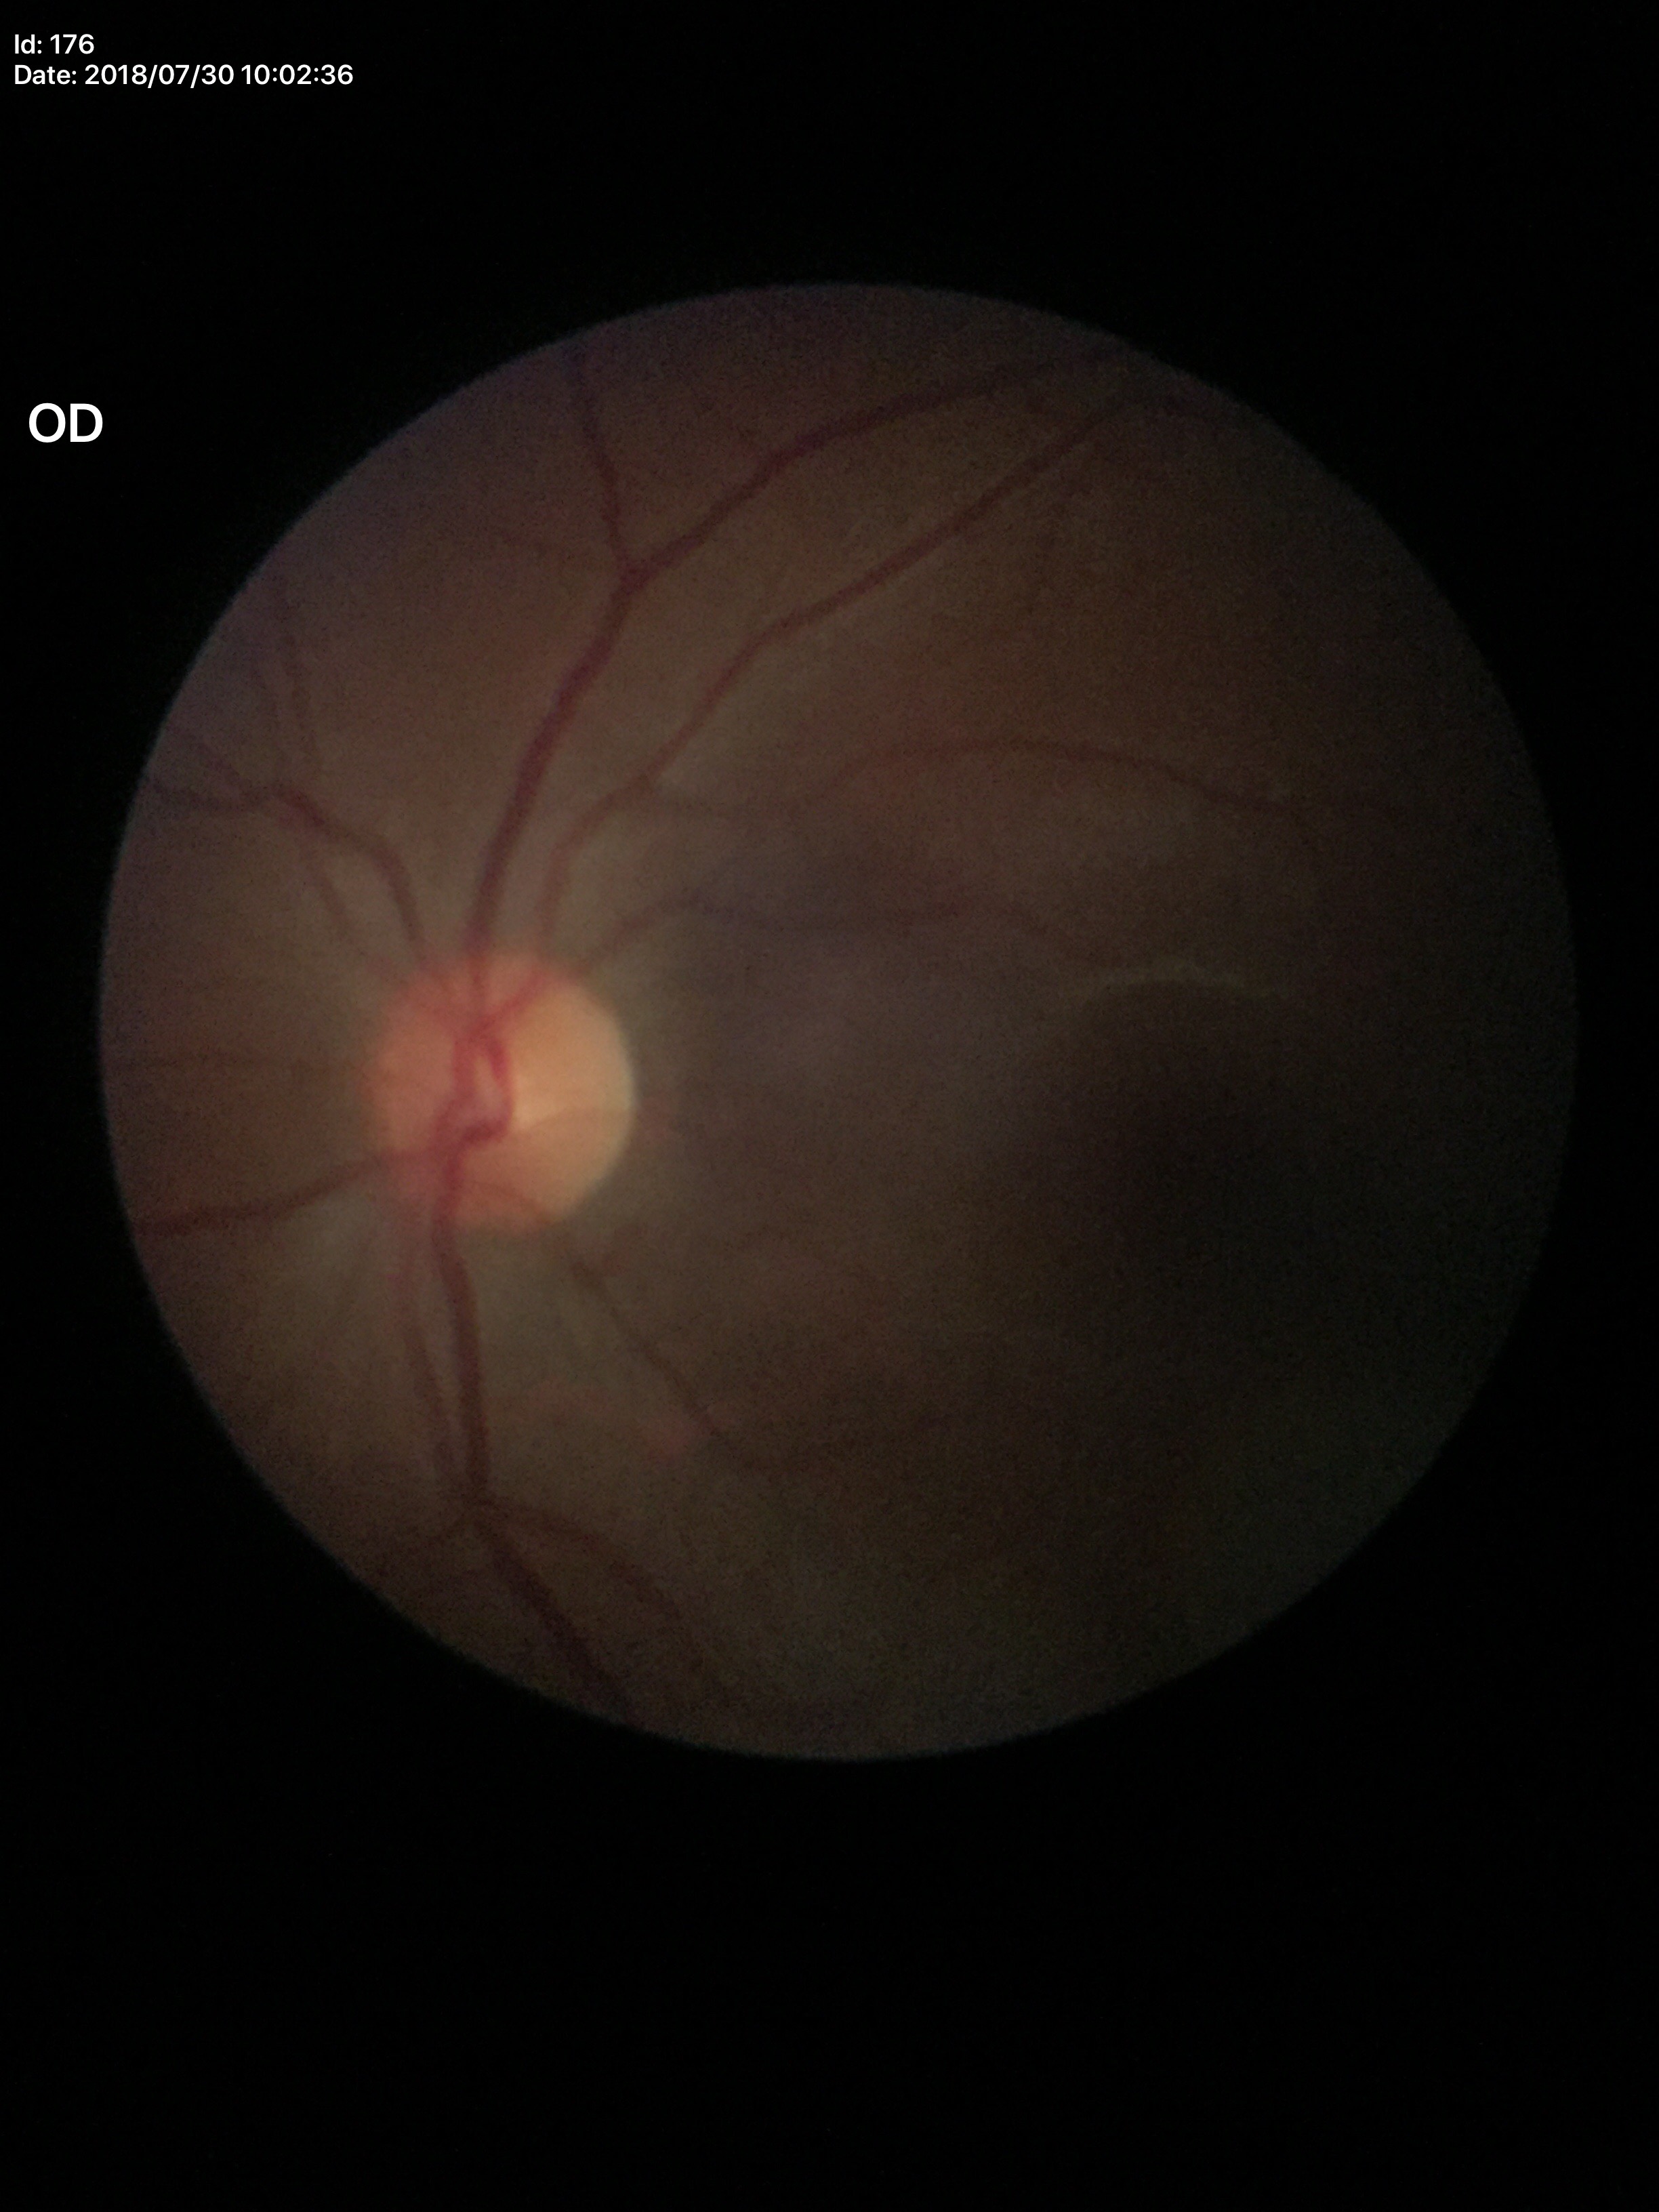 Optic disc analysis:
– ACDR — 0.18
– Glaucoma impression — no suspicious findings (unanimous normal call)
– VCDR — 0.45